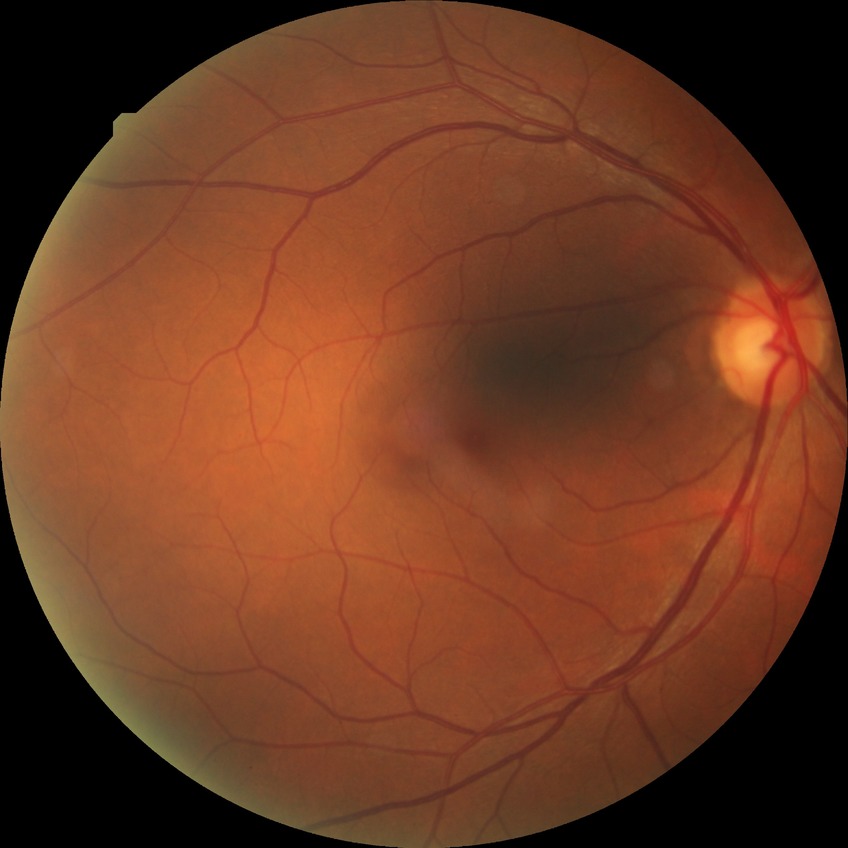
diabetic retinopathy (DR) = no diabetic retinopathy (NDR).